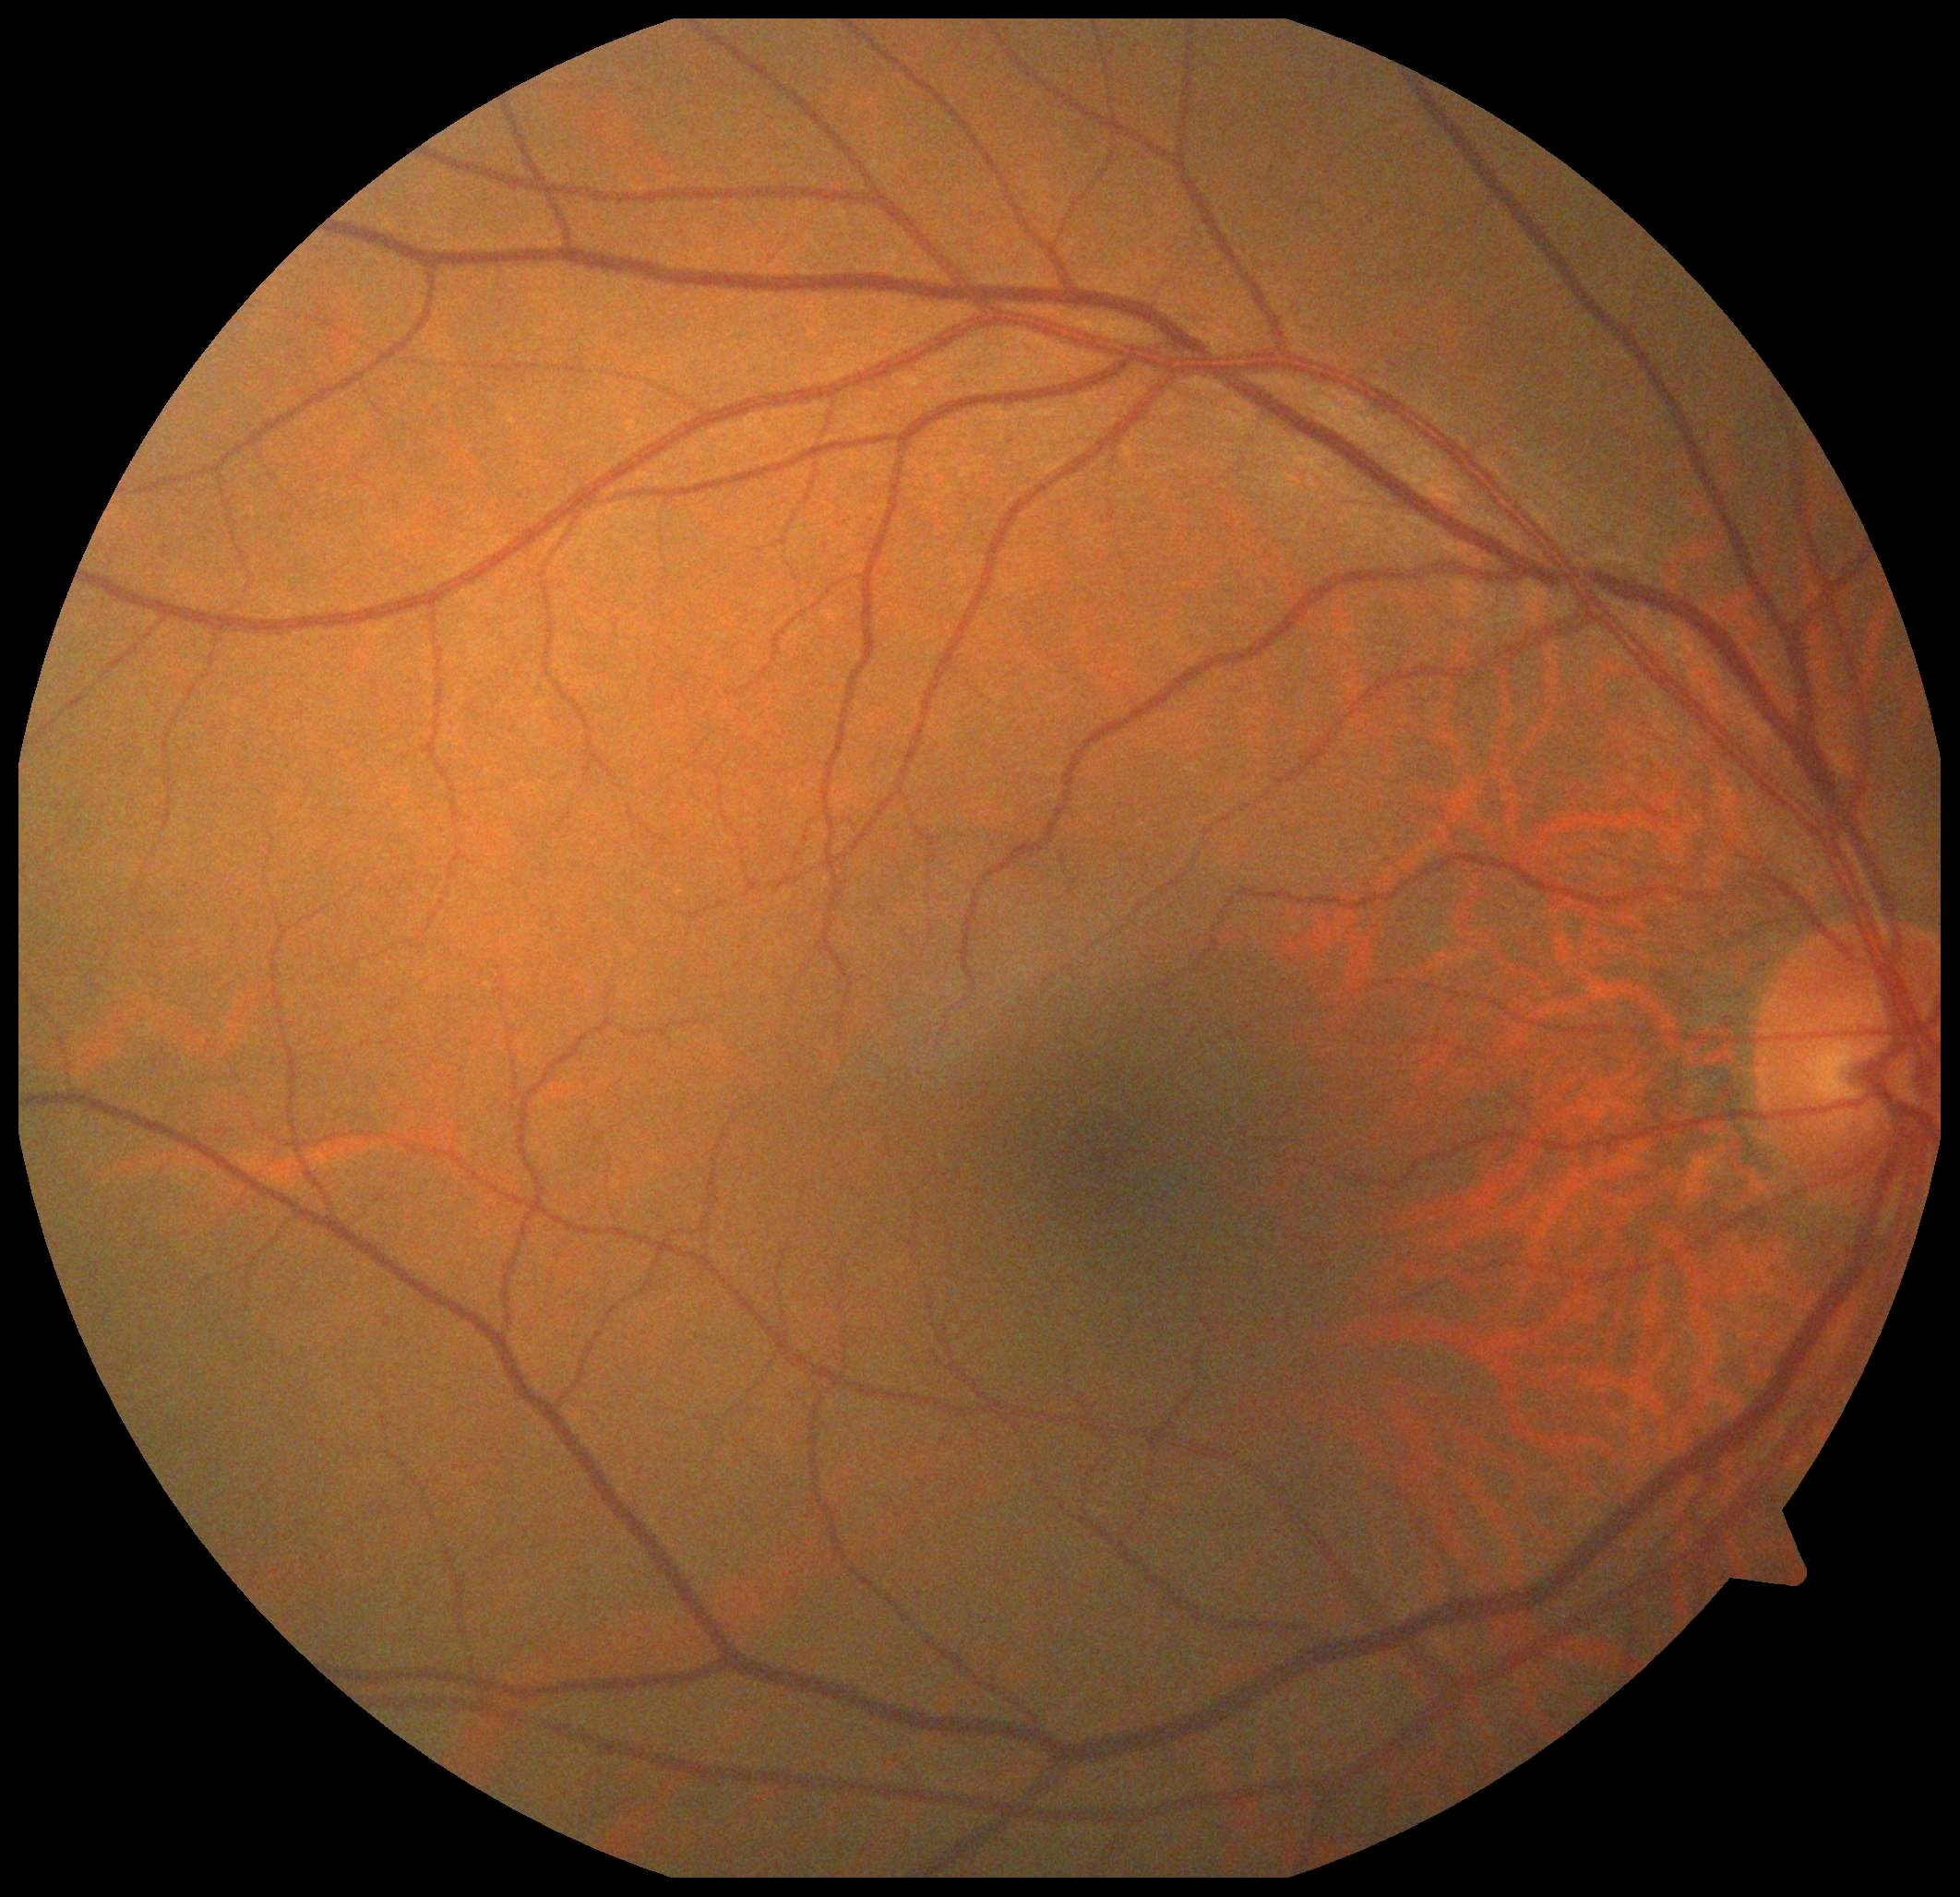 DR: 0.